45 degree fundus photograph, modified Davis grading, fundus photo.
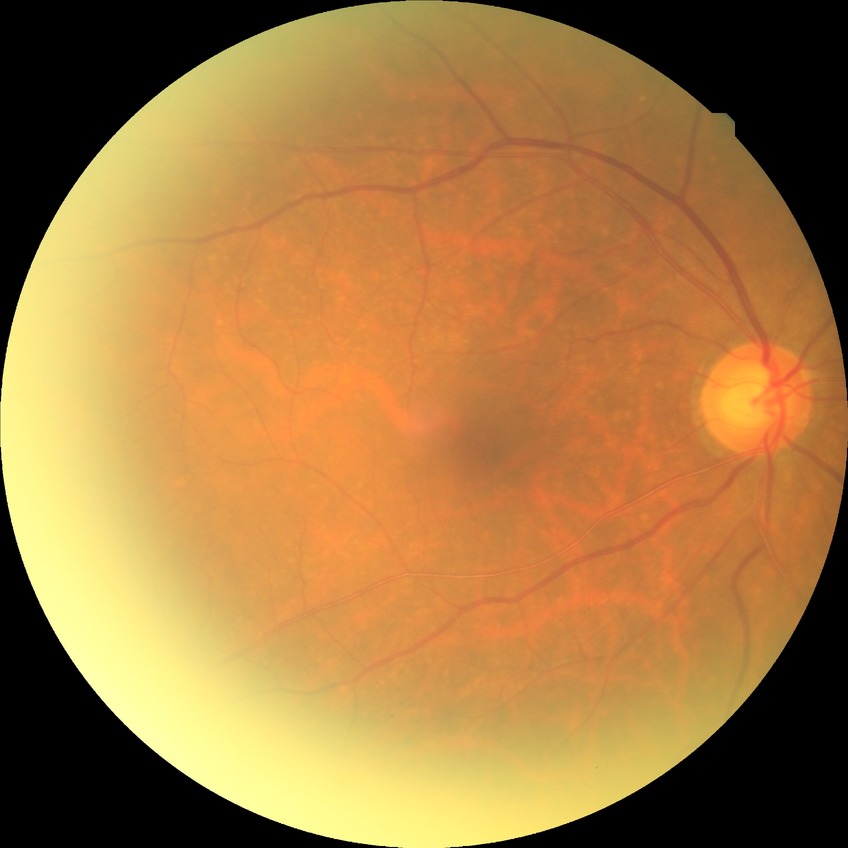
Davis stage: NDR.